35° FOV before cropping, image size 355x355, optic disc photograph.
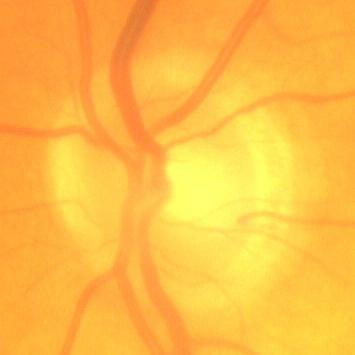 Showing no glaucomatous changes.